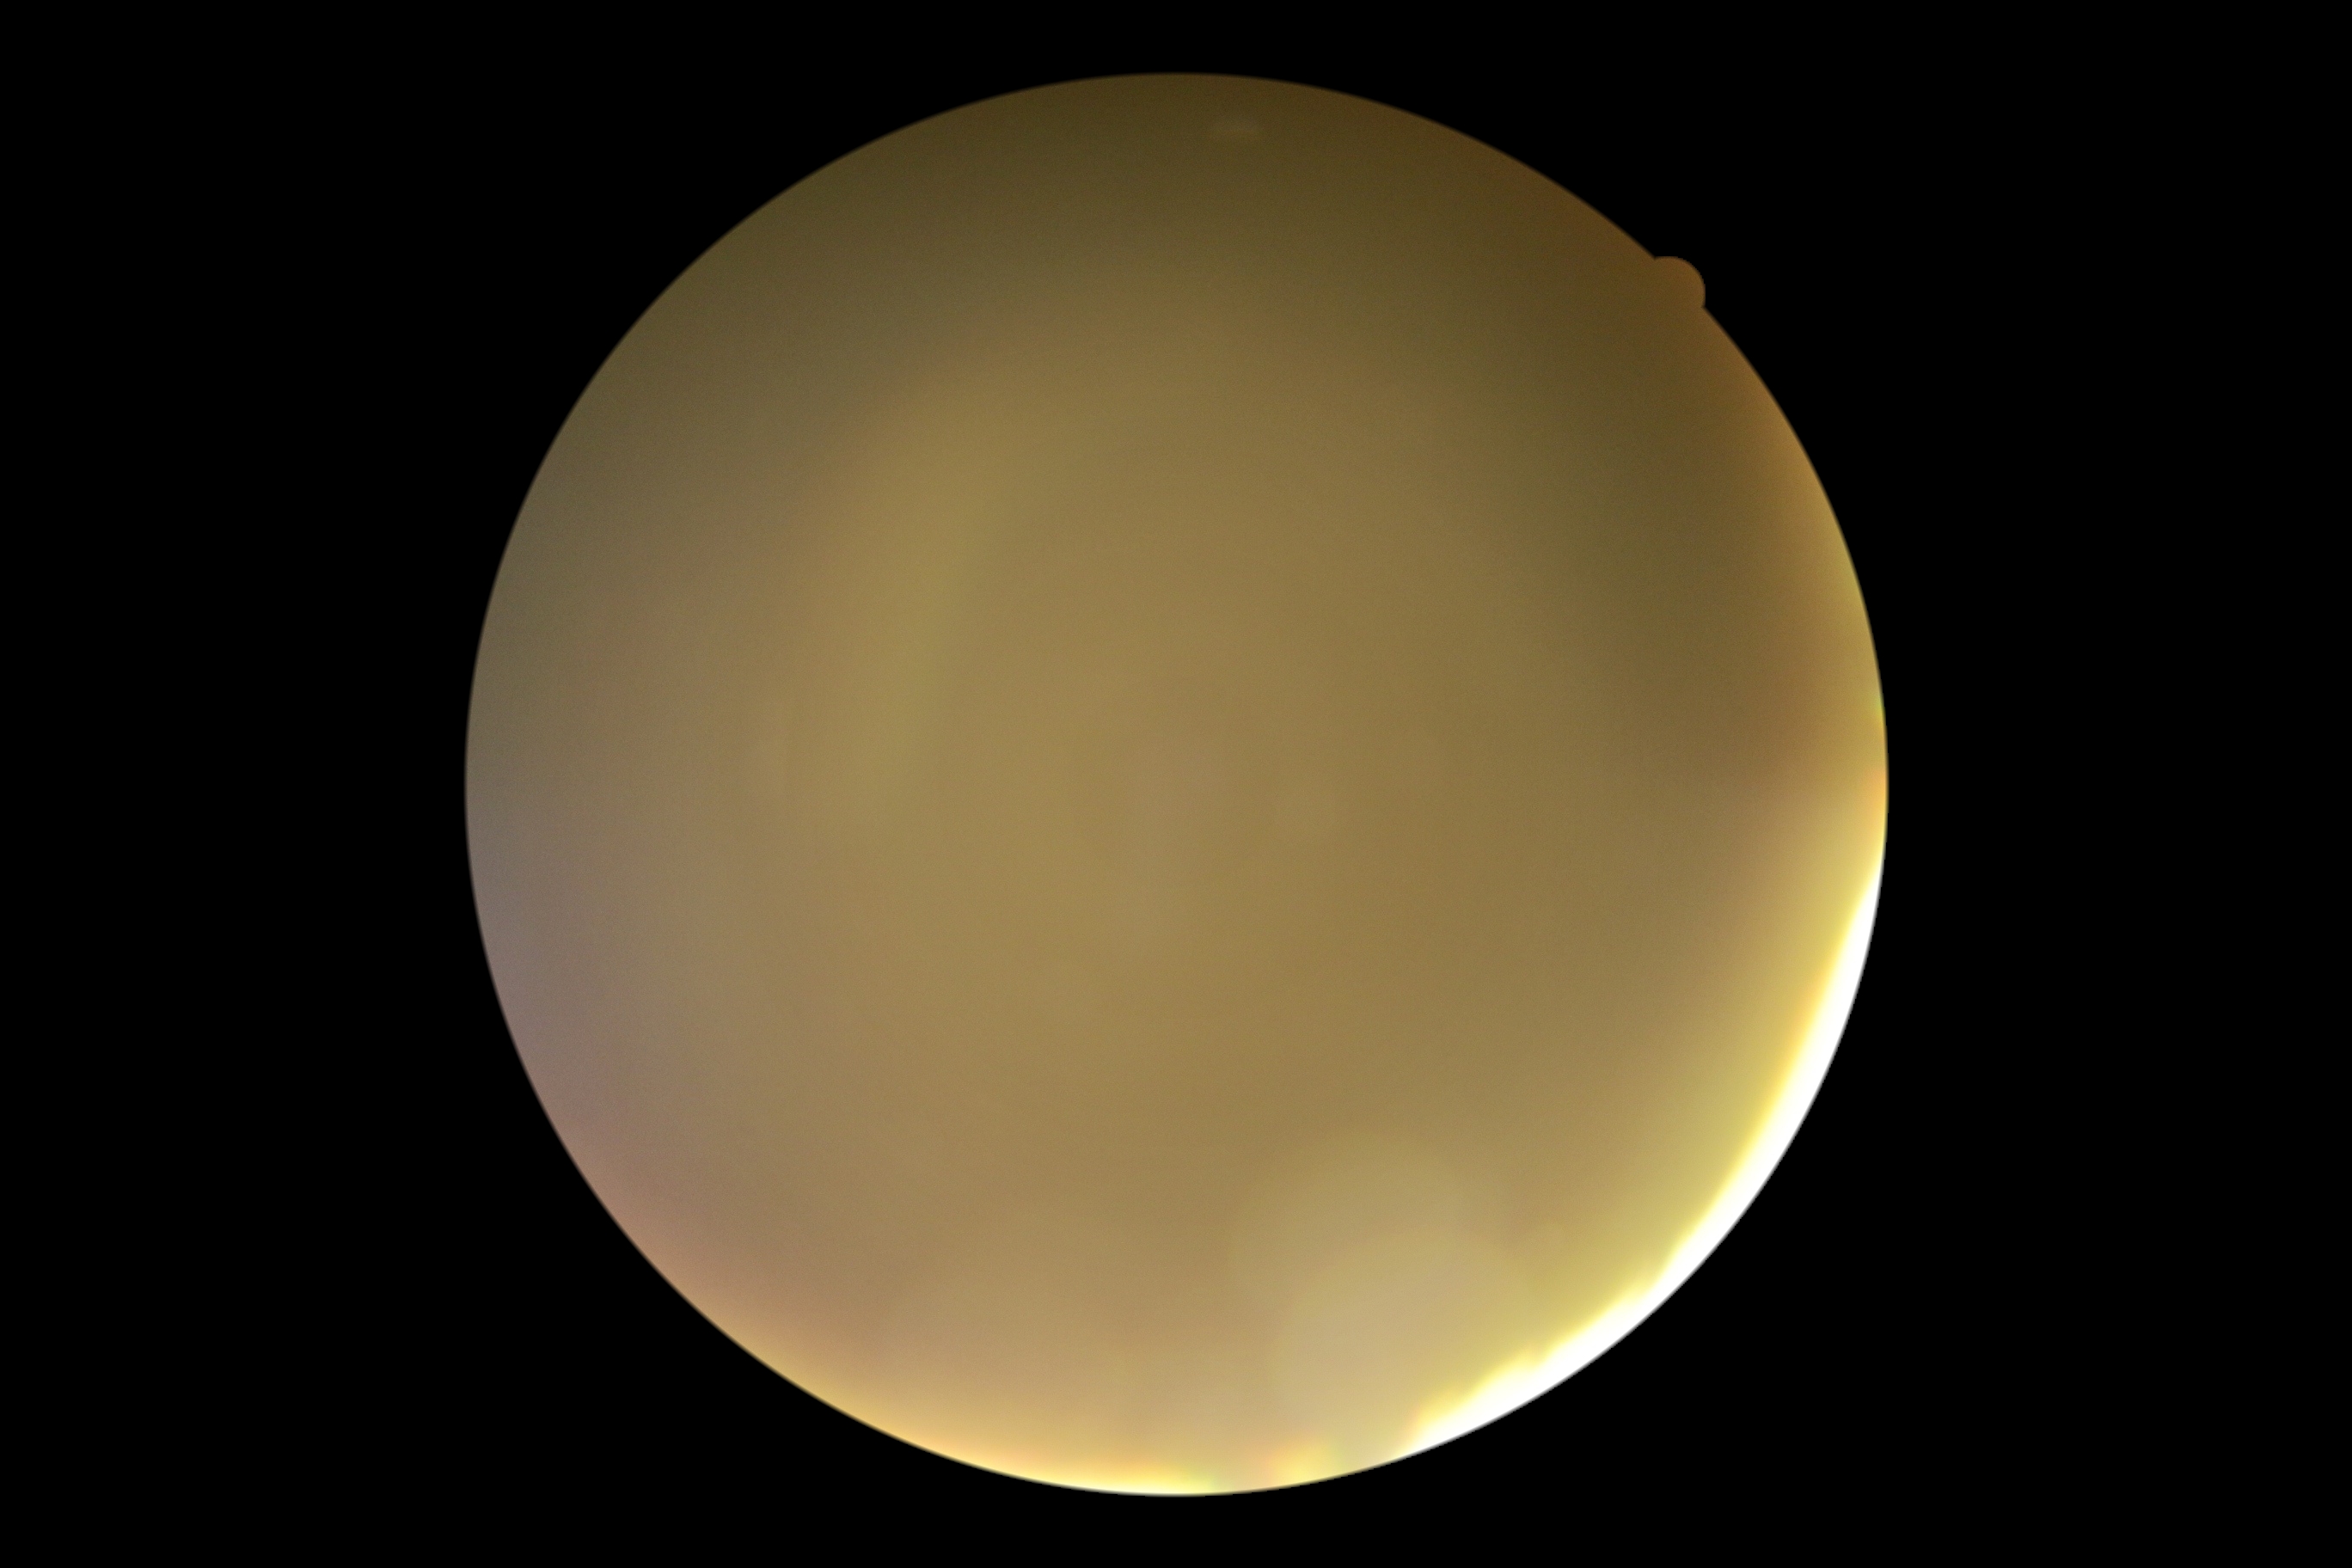
* diabetic retinopathy grade — ungradable
* image quality — insufficient for DR assessment